1440 x 1080 pixels. Captured with the Natus RetCam Envision (130° field of view). Infant wide-field fundus photograph: 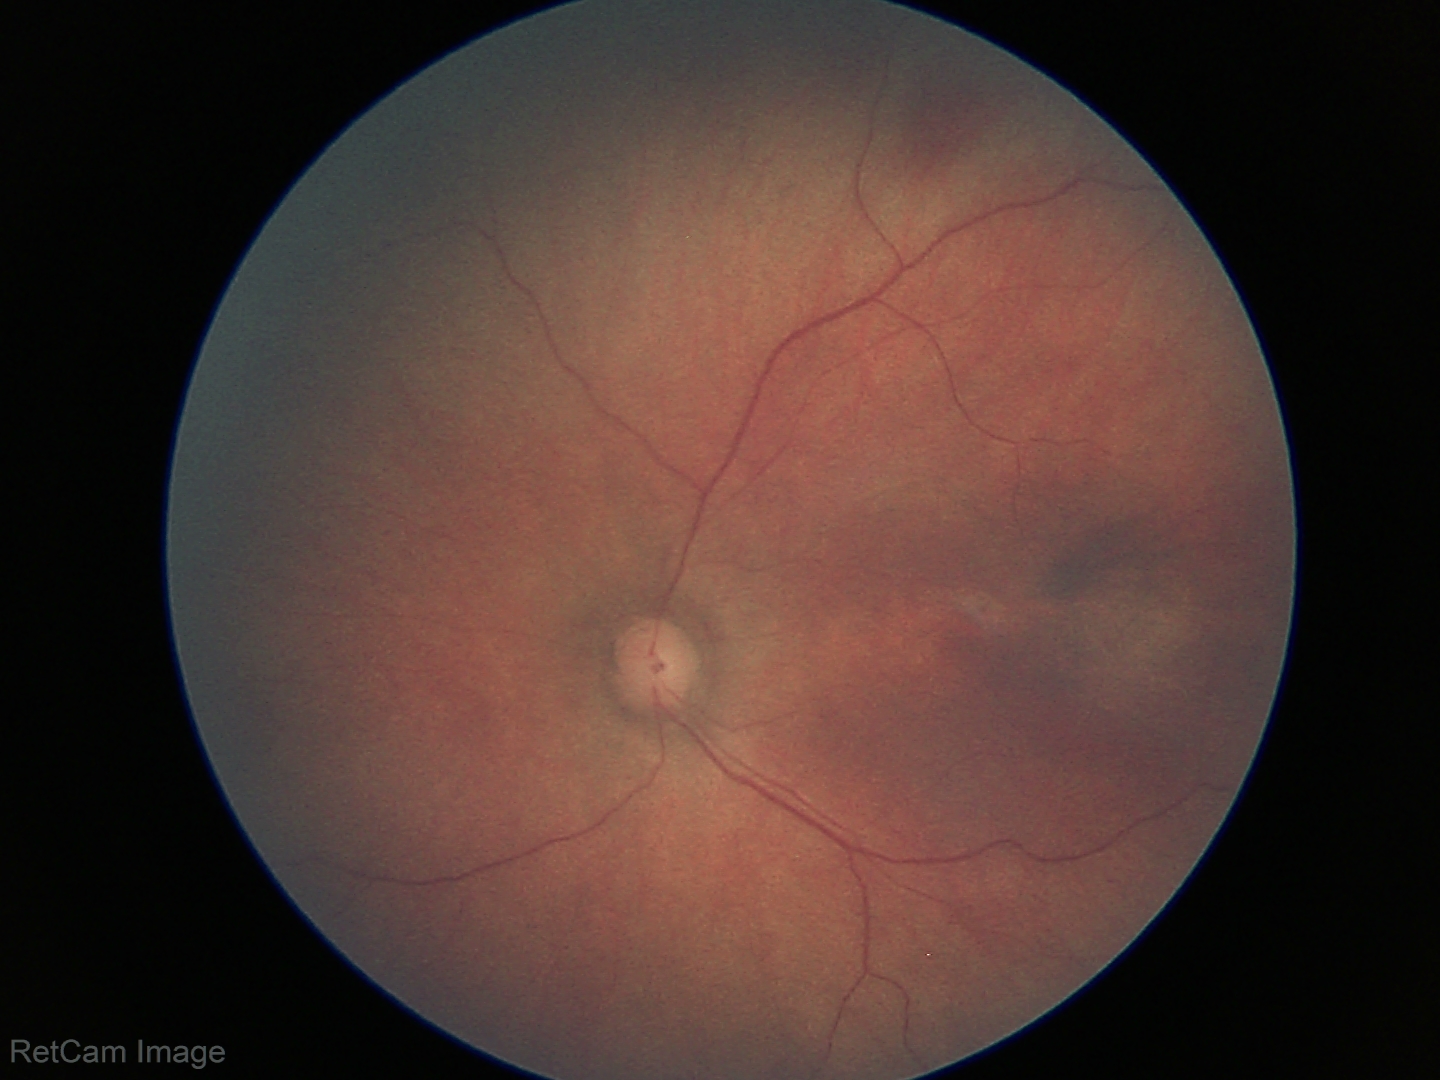

Assessment: normal fundus examination.